45-degree field of view — 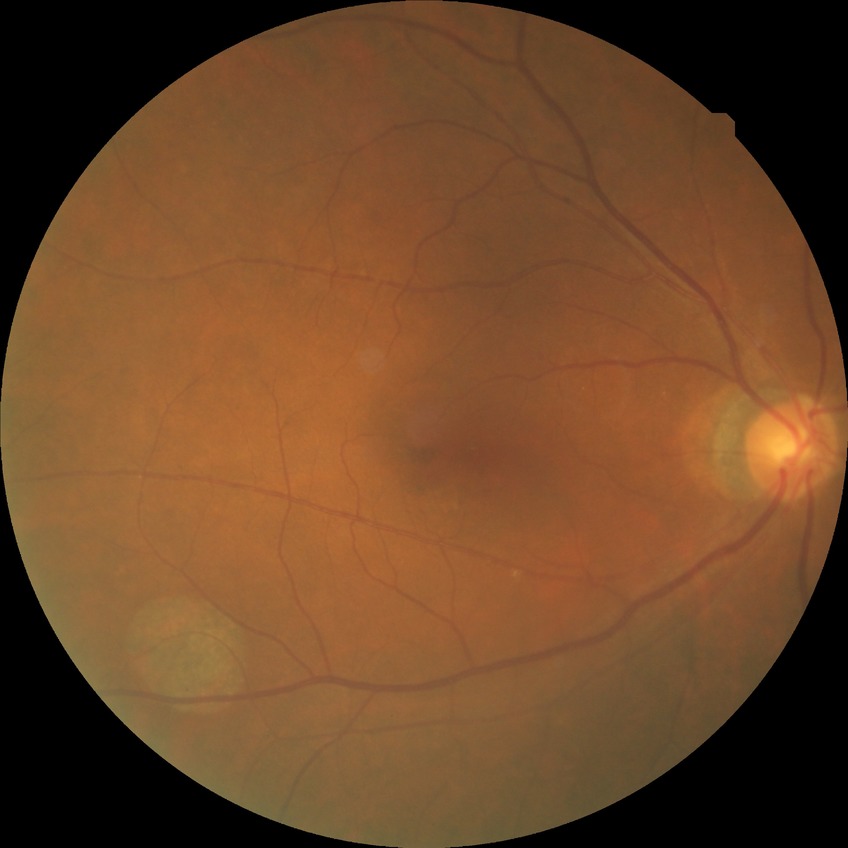

davis_grade: NDR (no diabetic retinopathy)